Image size 1932x1916. 45° field of view:
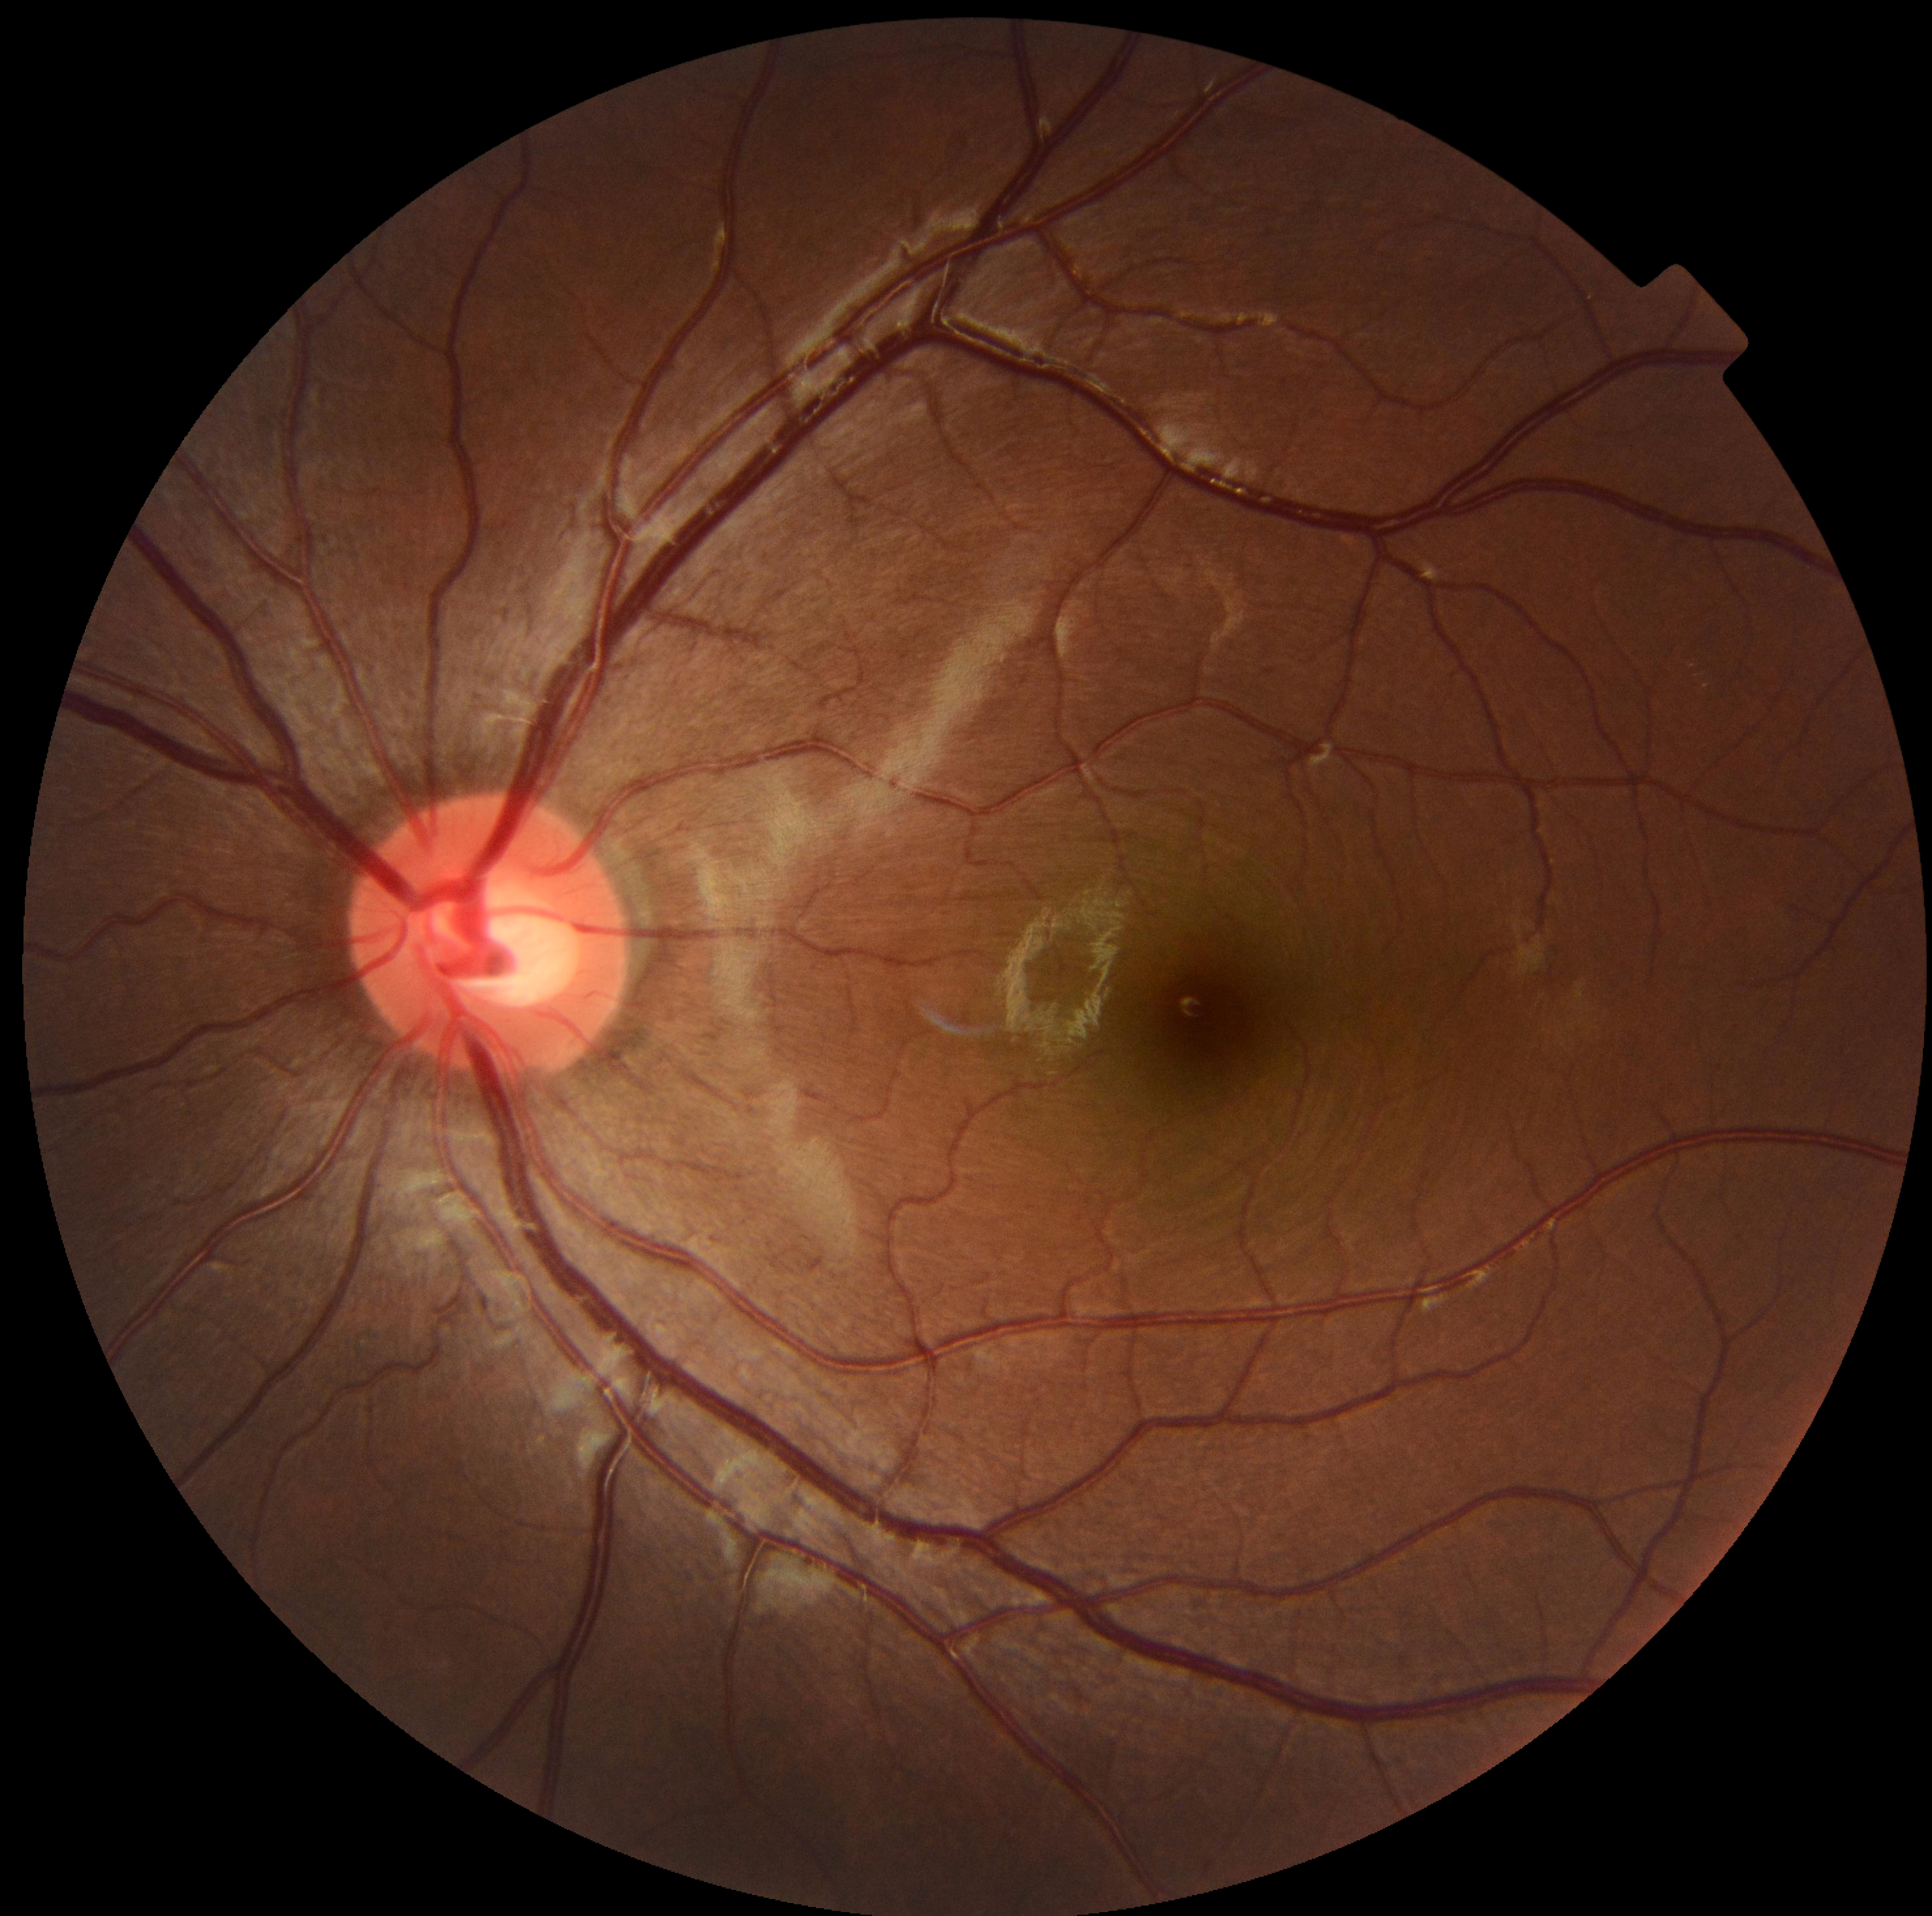

{
  "dr_grade": "0"
}